Davis DR grading; without pupil dilation; fundus photo
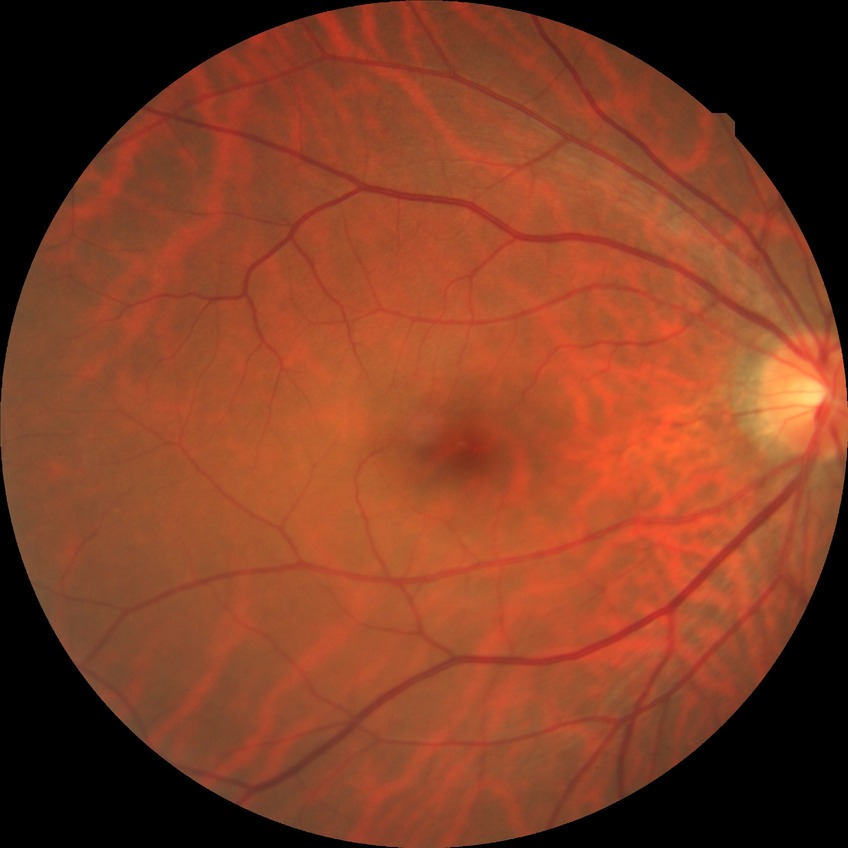

Diabetic retinopathy (DR) is NDR (no diabetic retinopathy).